2212x1659. FOV: 45 degrees. Fundus photo.
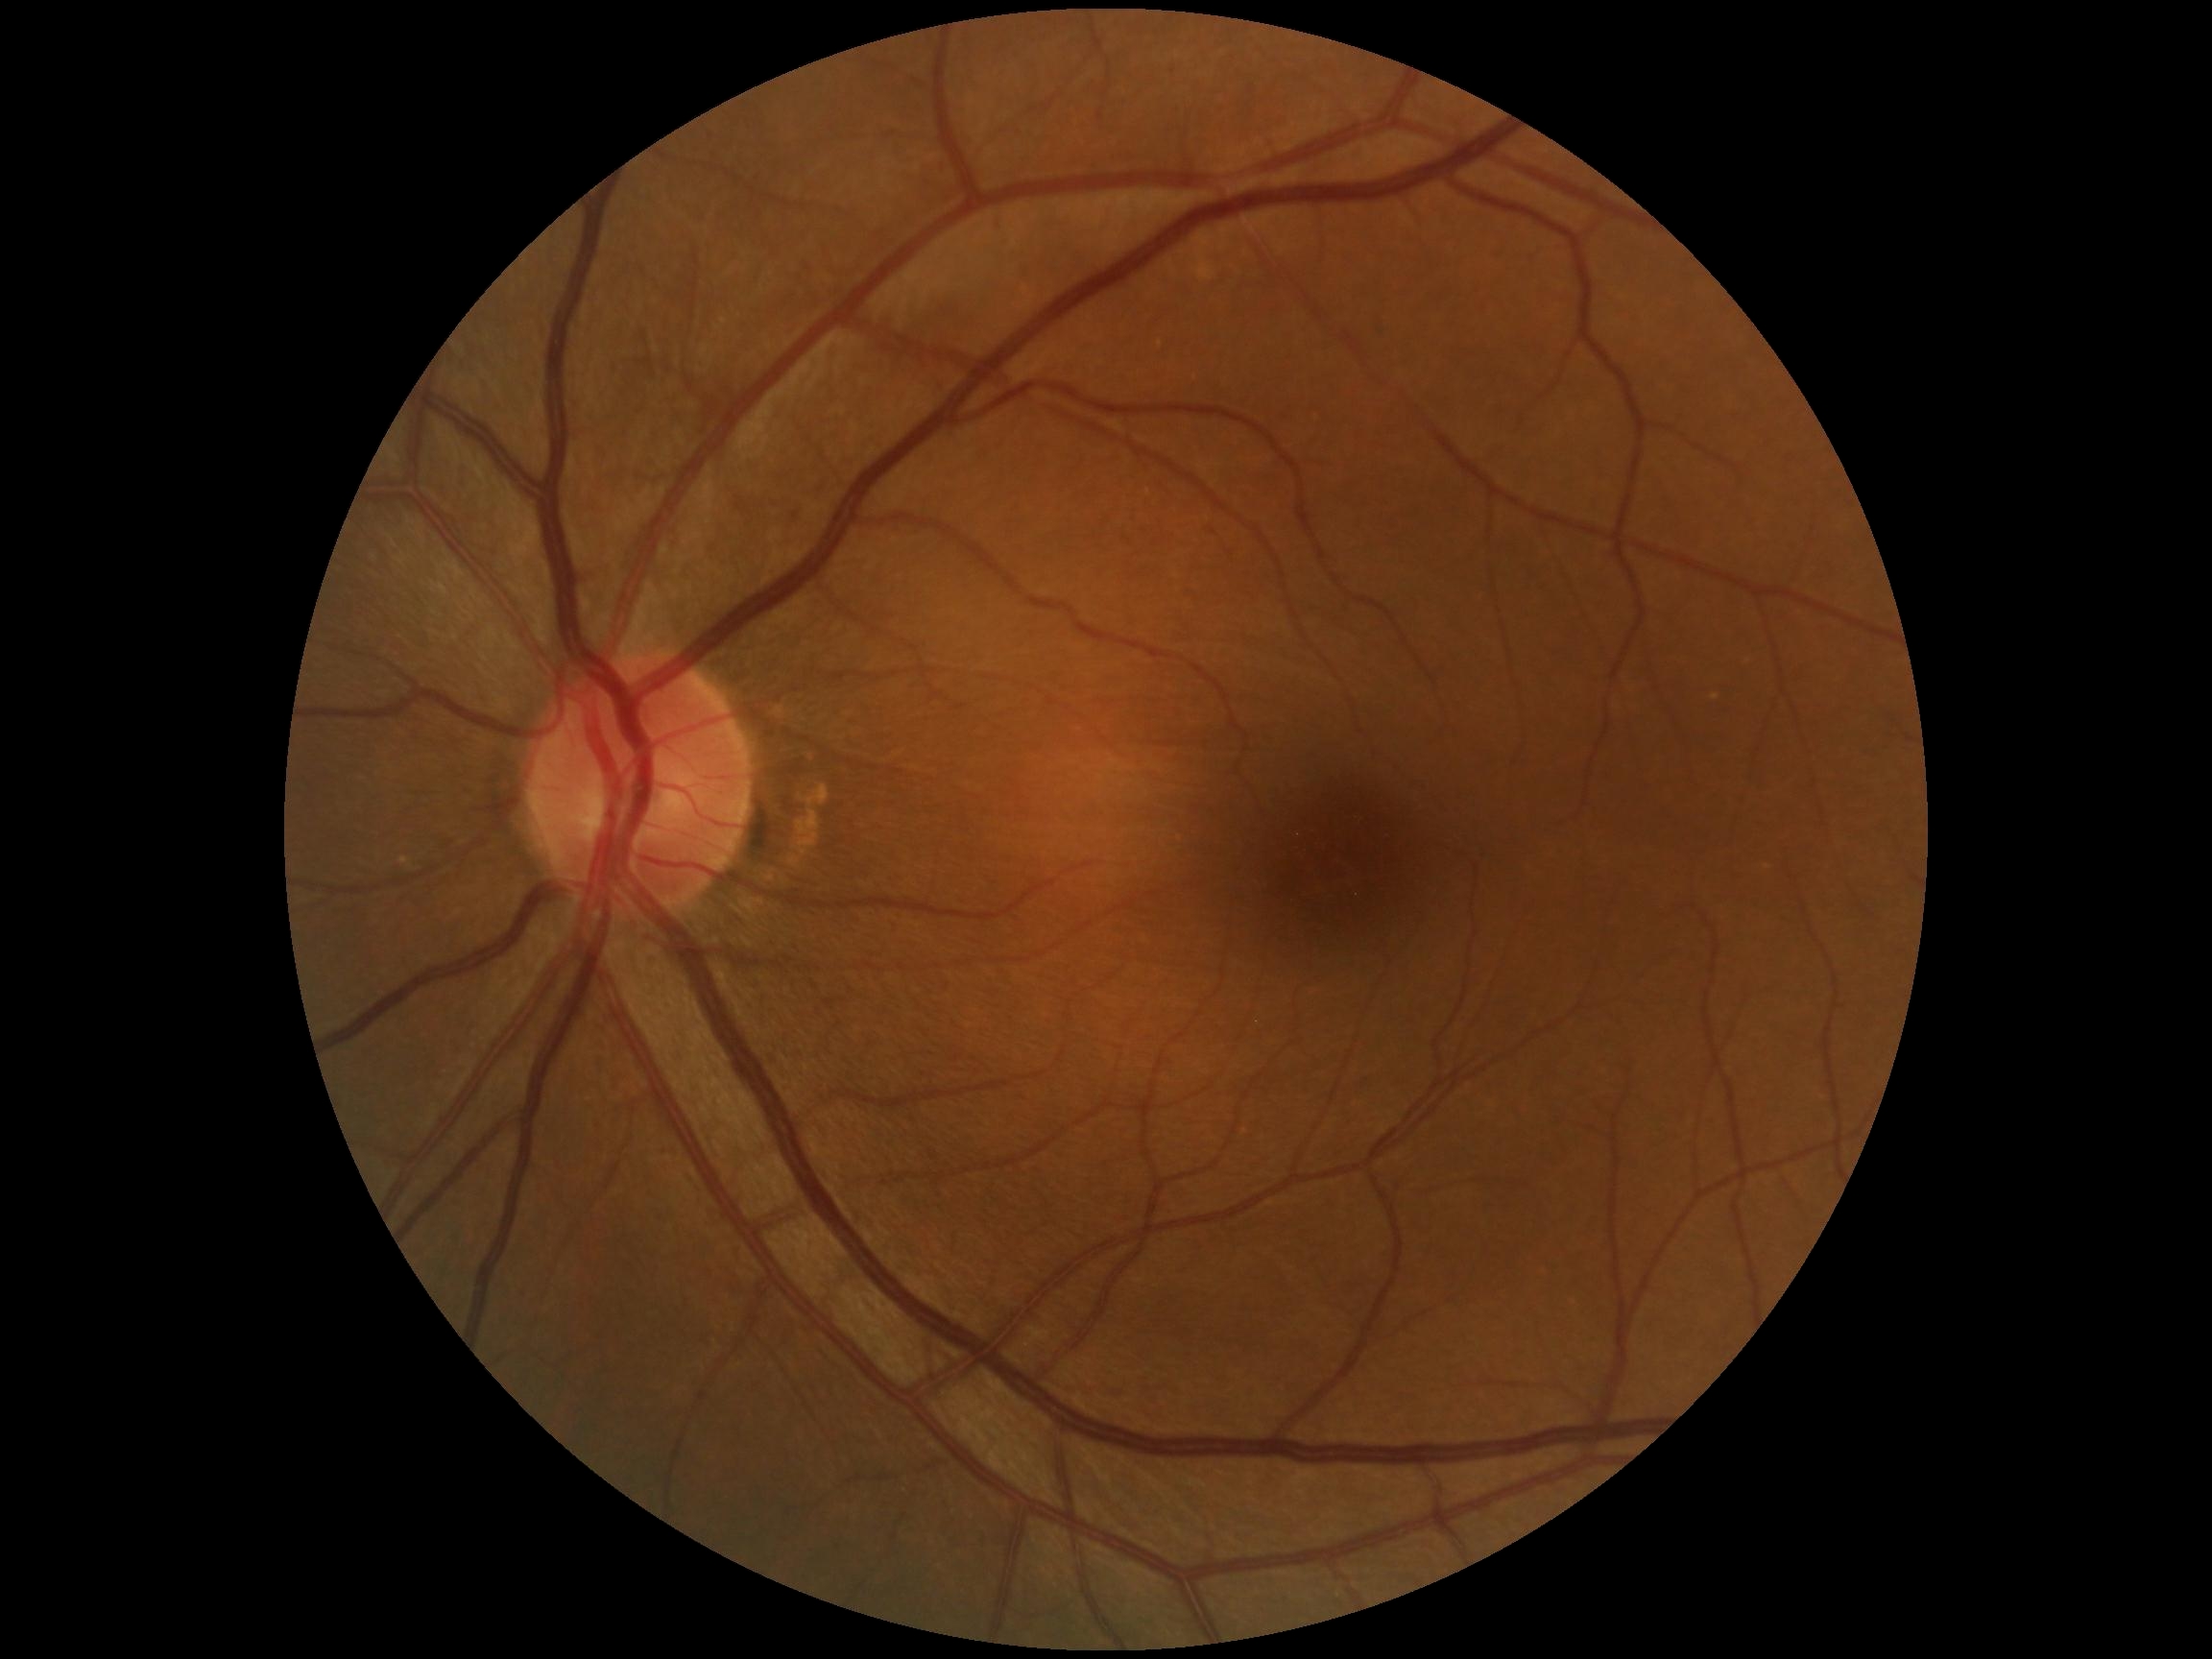
Diabetic retinopathy is grade 0.
No DR findings.